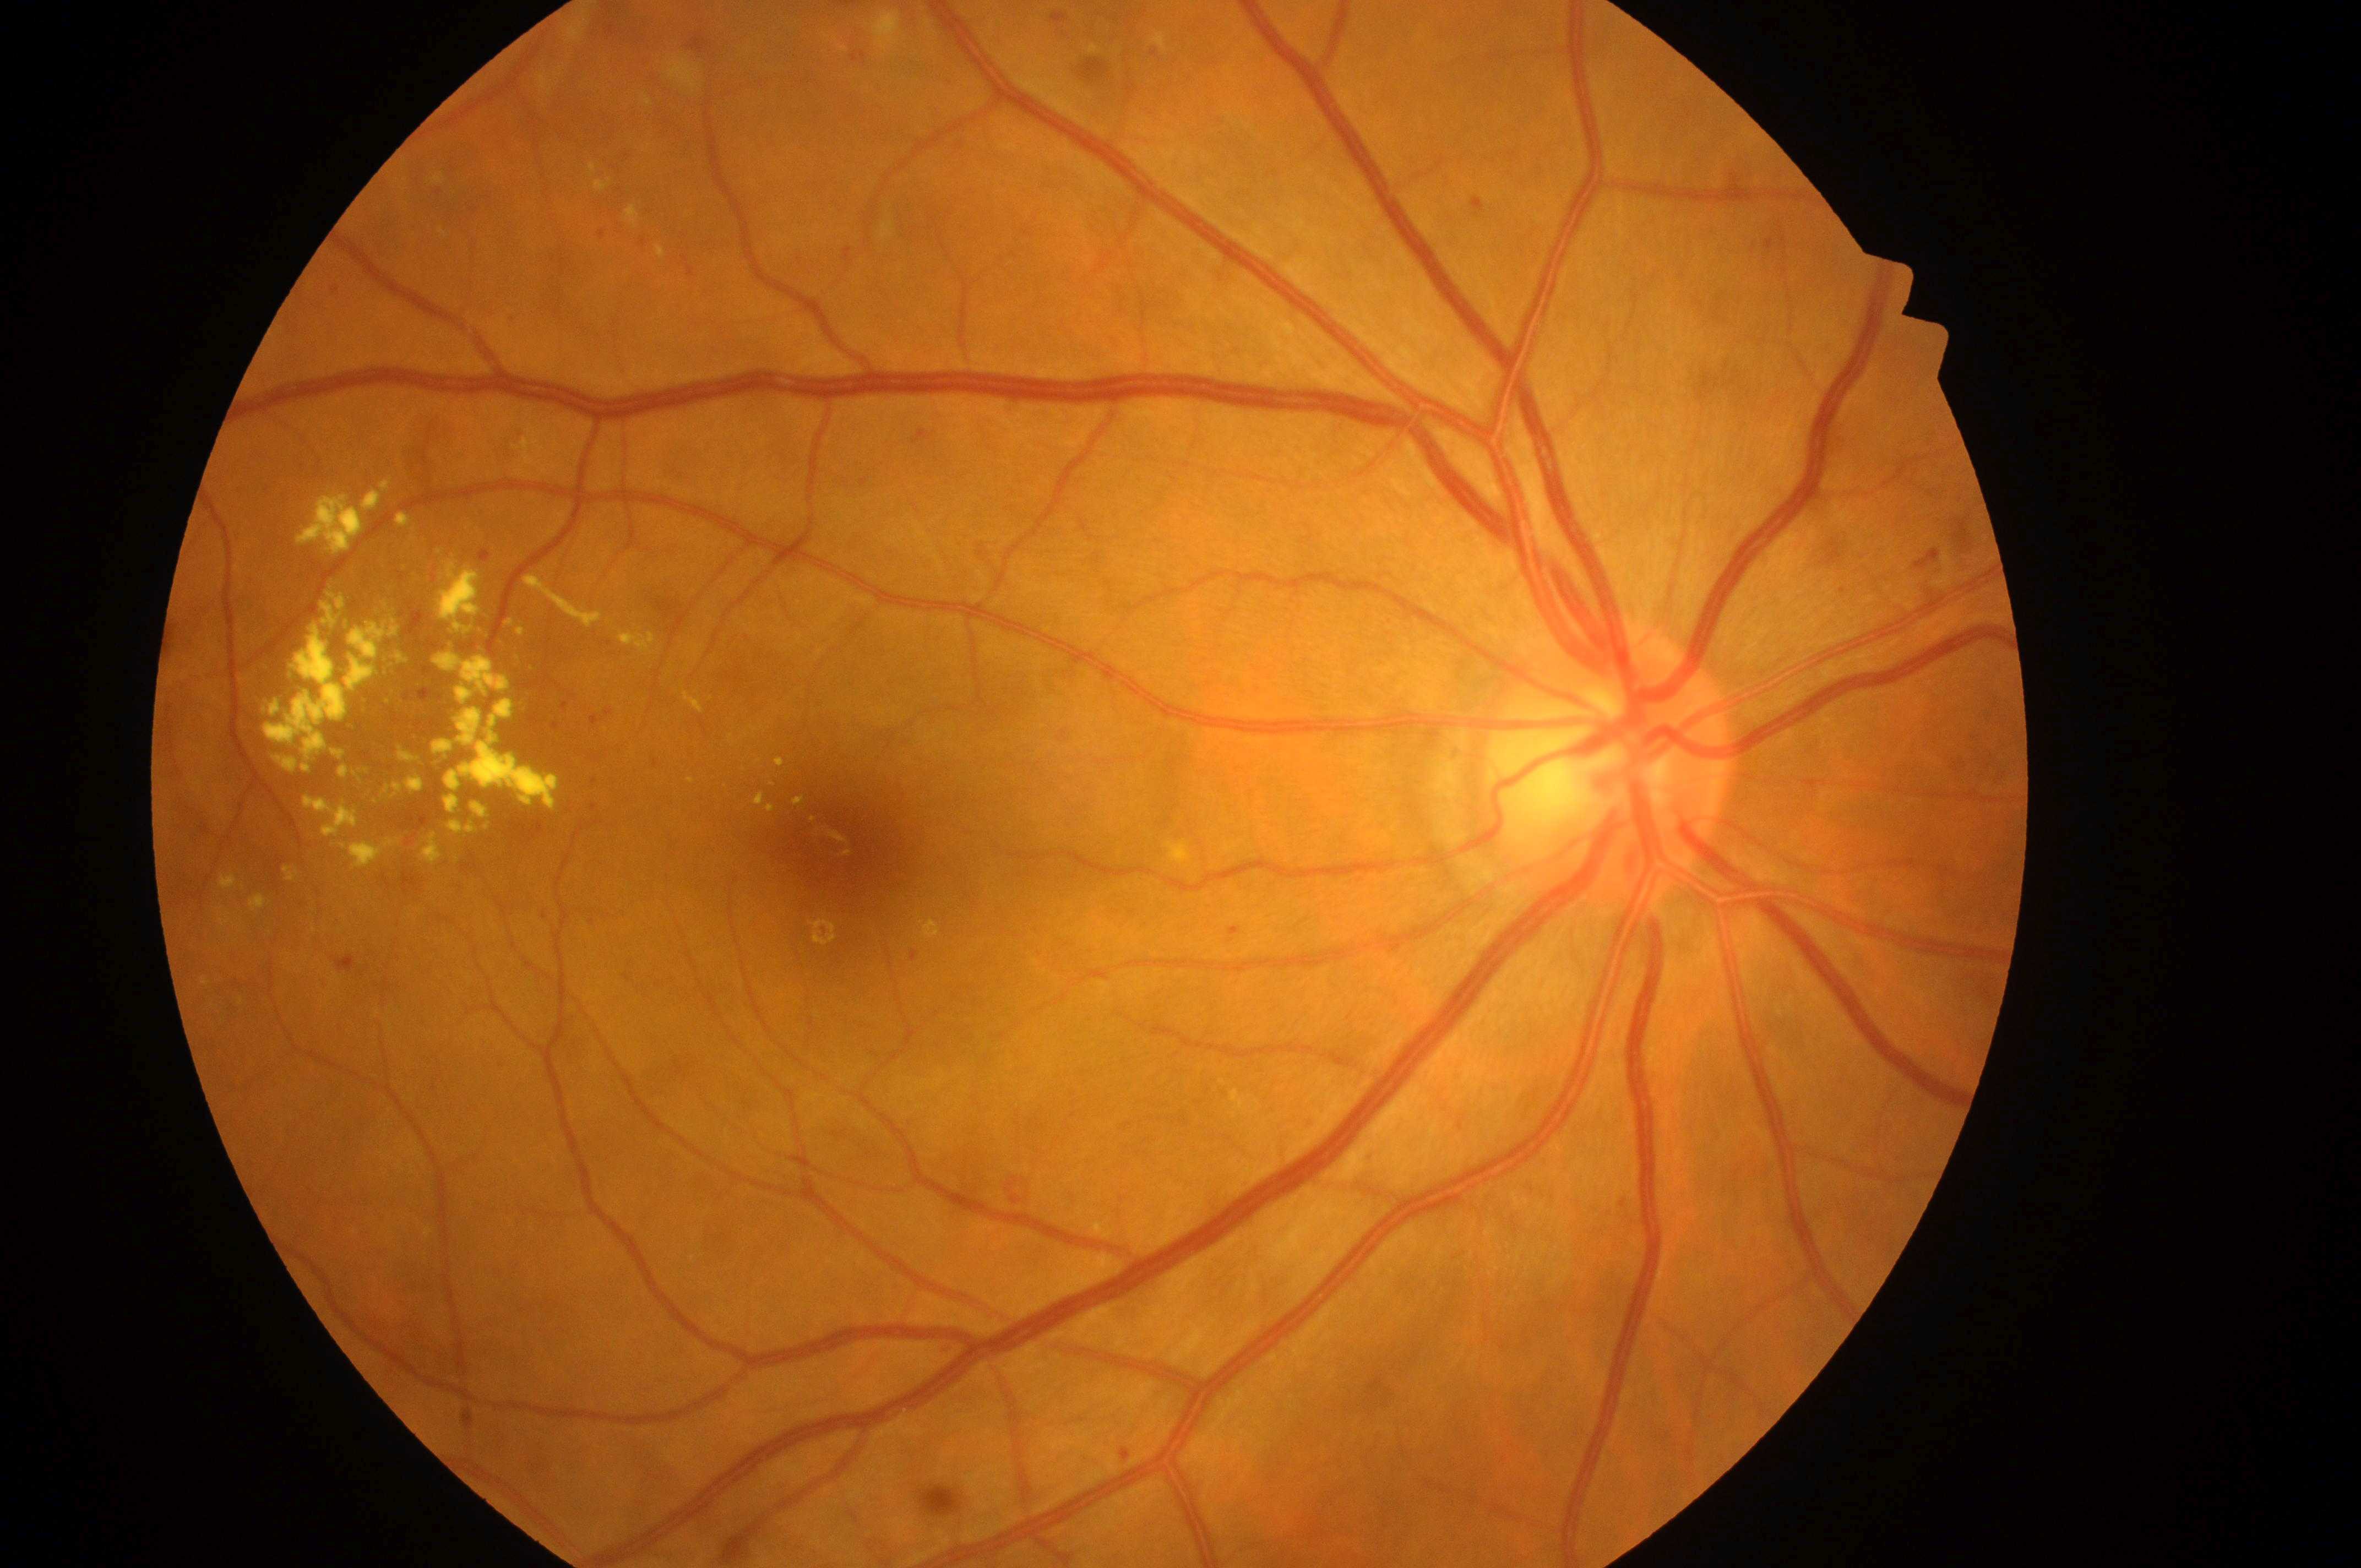 DR is grade 2. The ONH is at (x=1590, y=781). Fovea: (x=844, y=853). The image shows the right eye. DME grade is 2.